Natus RetCam Envision, 130° FOV. 1440 by 1080 pixels. Wide-field fundus photograph of an infant.
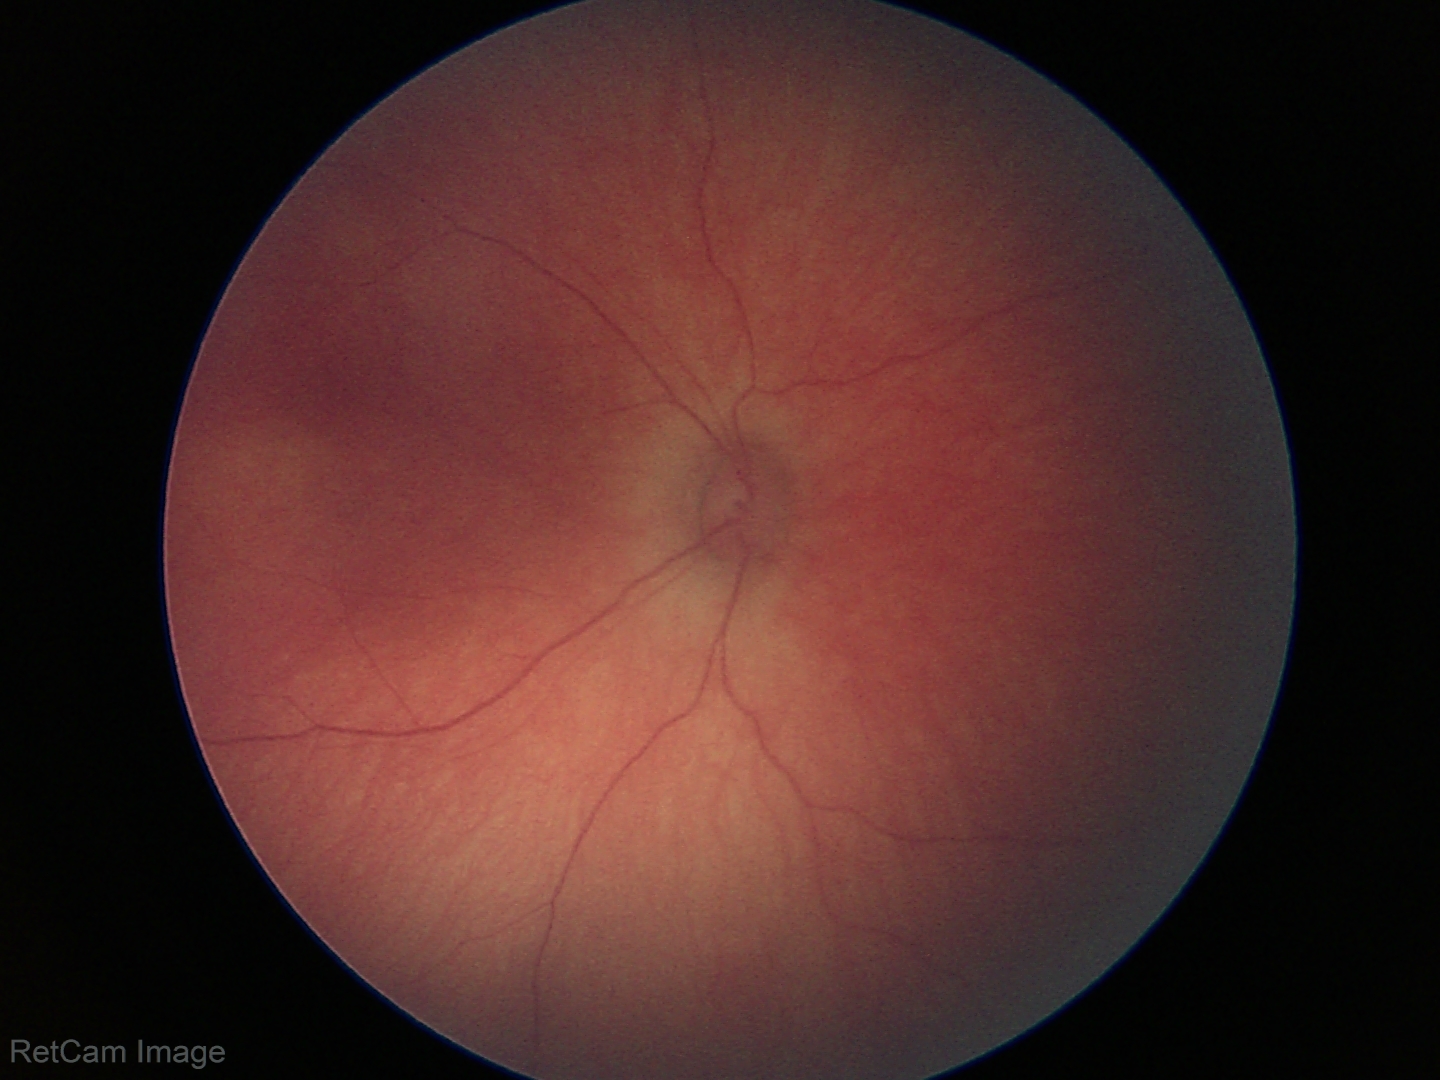
Screening diagnosis: no abnormal retinal findings.